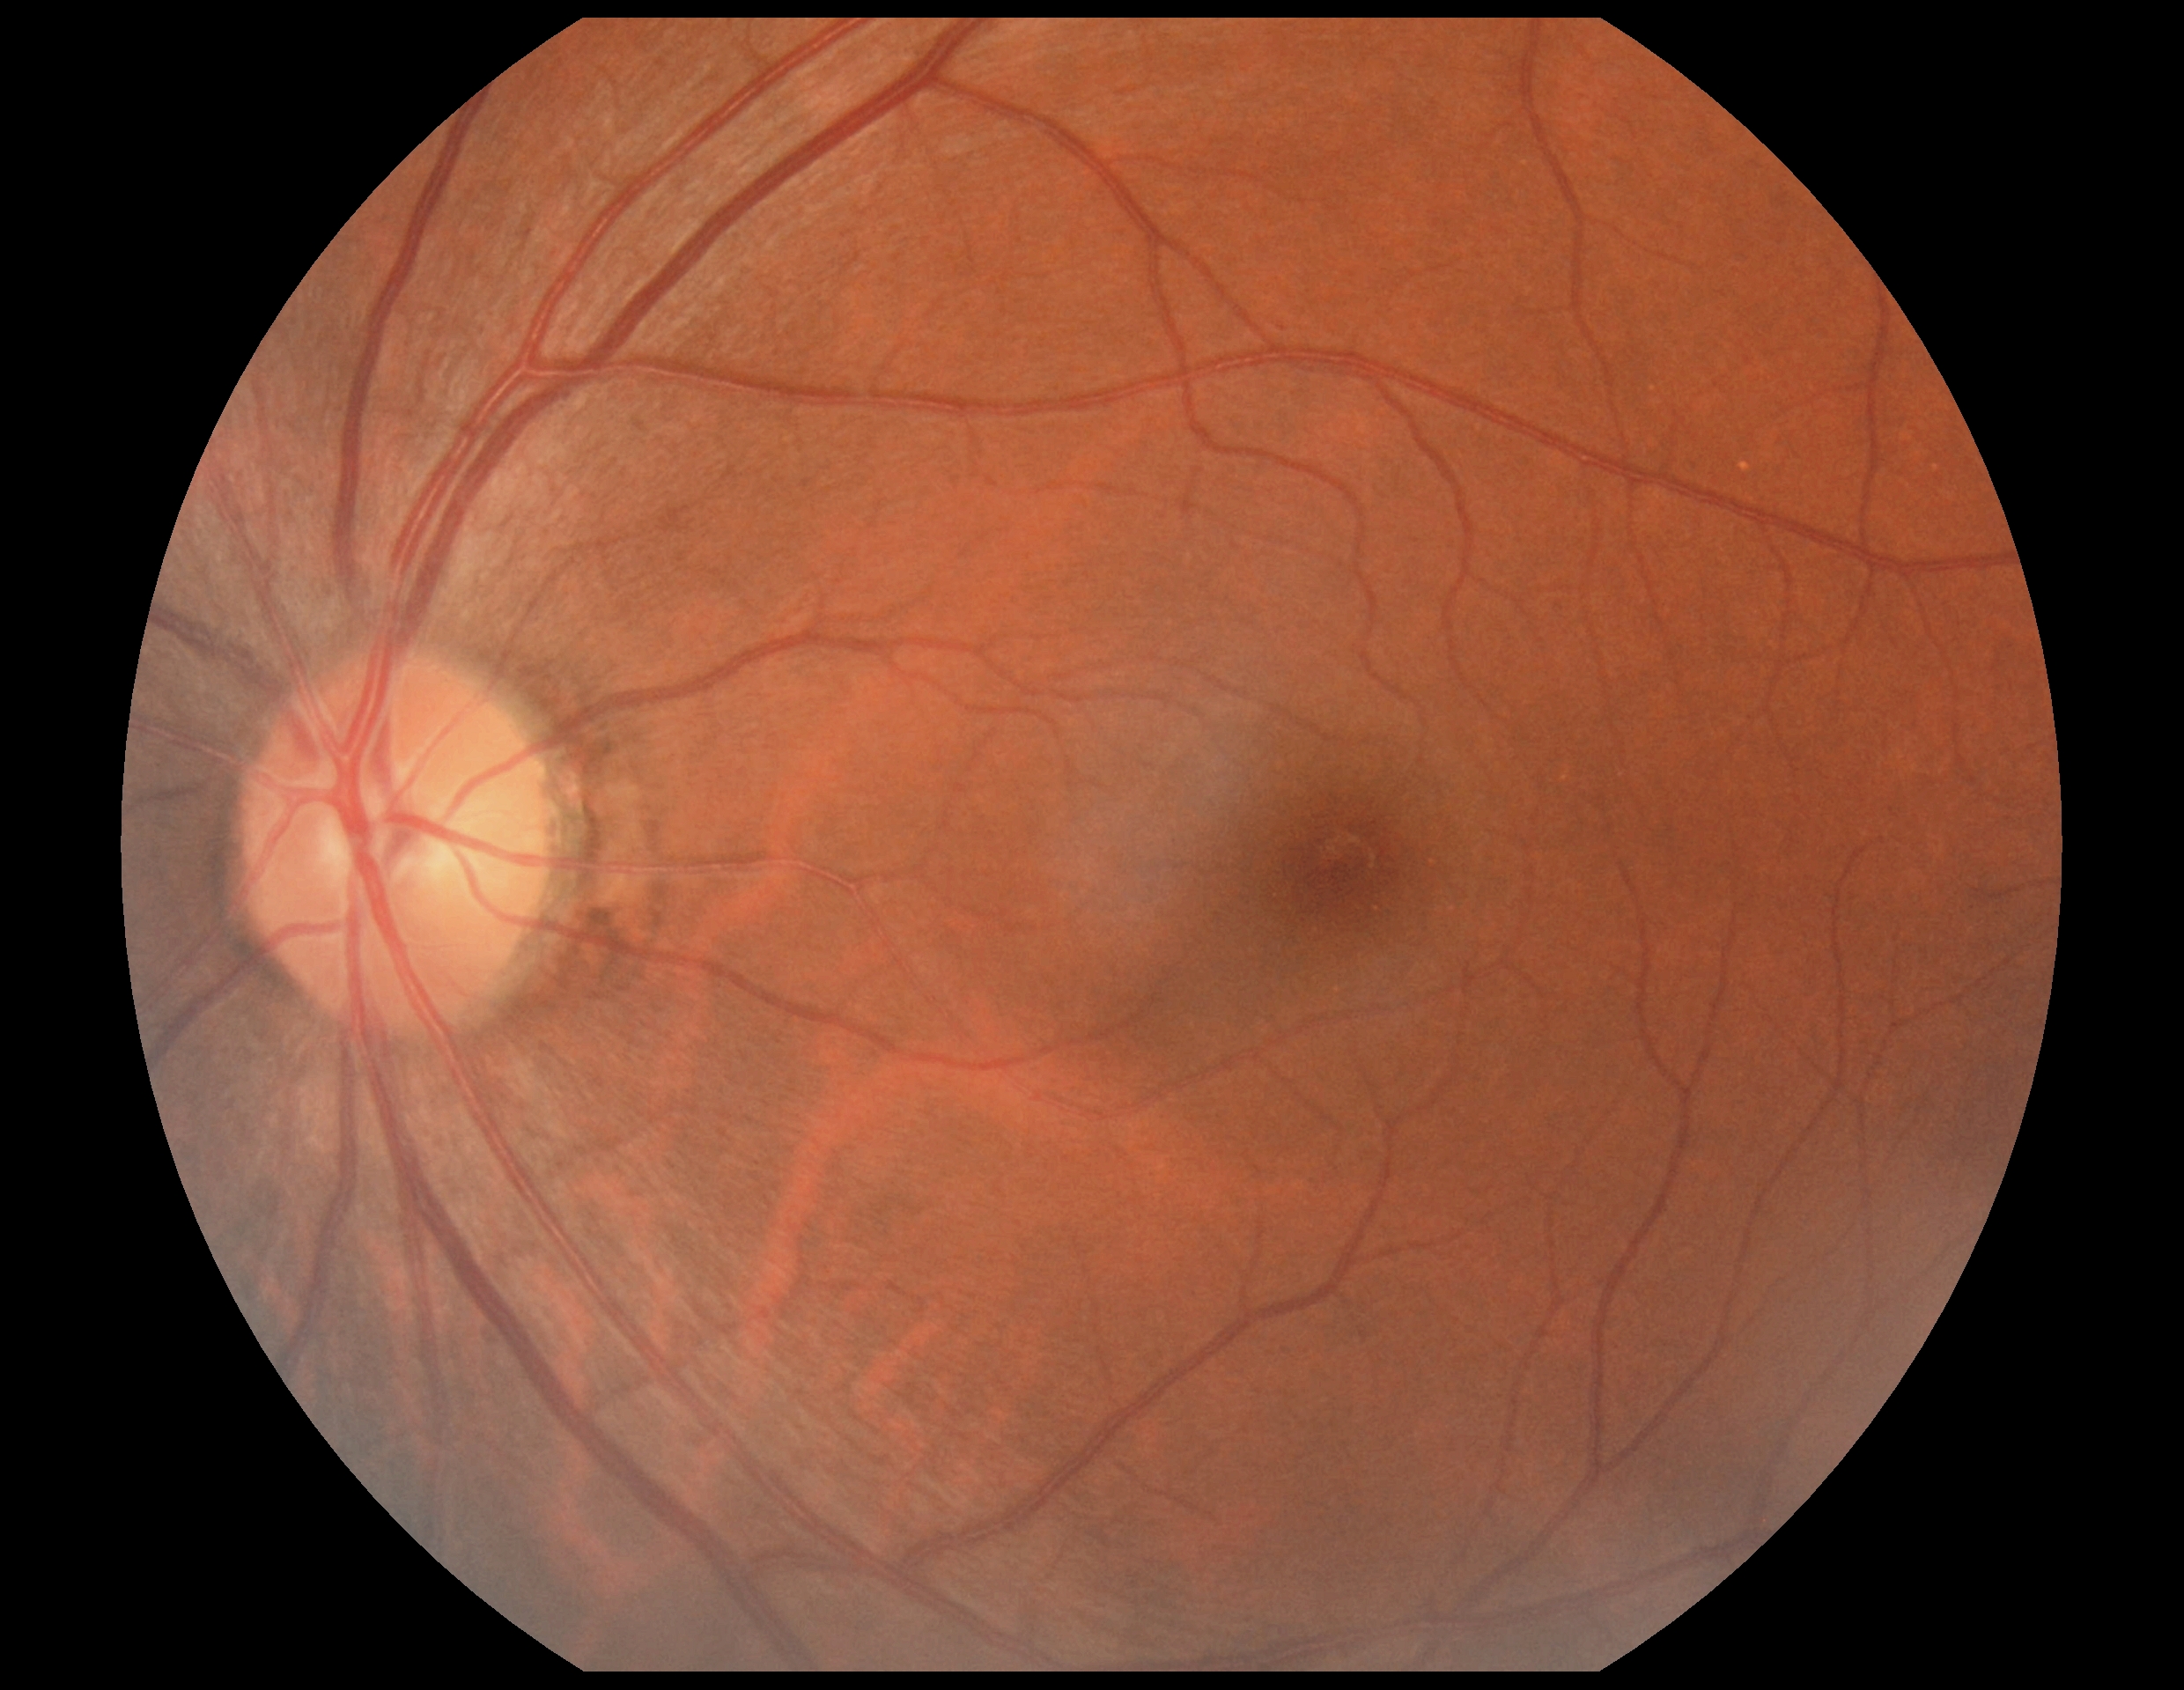

No DR findings. DR grade: 0/4 — no visible signs of diabetic retinopathy.